130° field of view (Clarity RetCam 3). Wide-field fundus photograph from neonatal ROP screening: 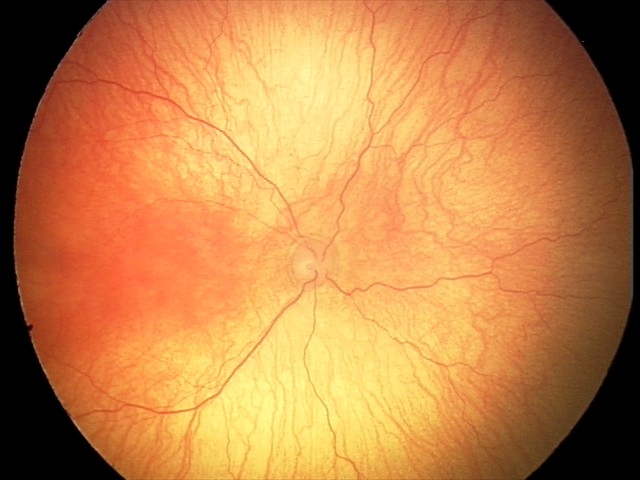 Series diagnosed as aggressive ROP (A-ROP) — rapidly progressive severe ROP with prominent plus disease, often without classic stage progression.